Posterior pole color fundus photograph: 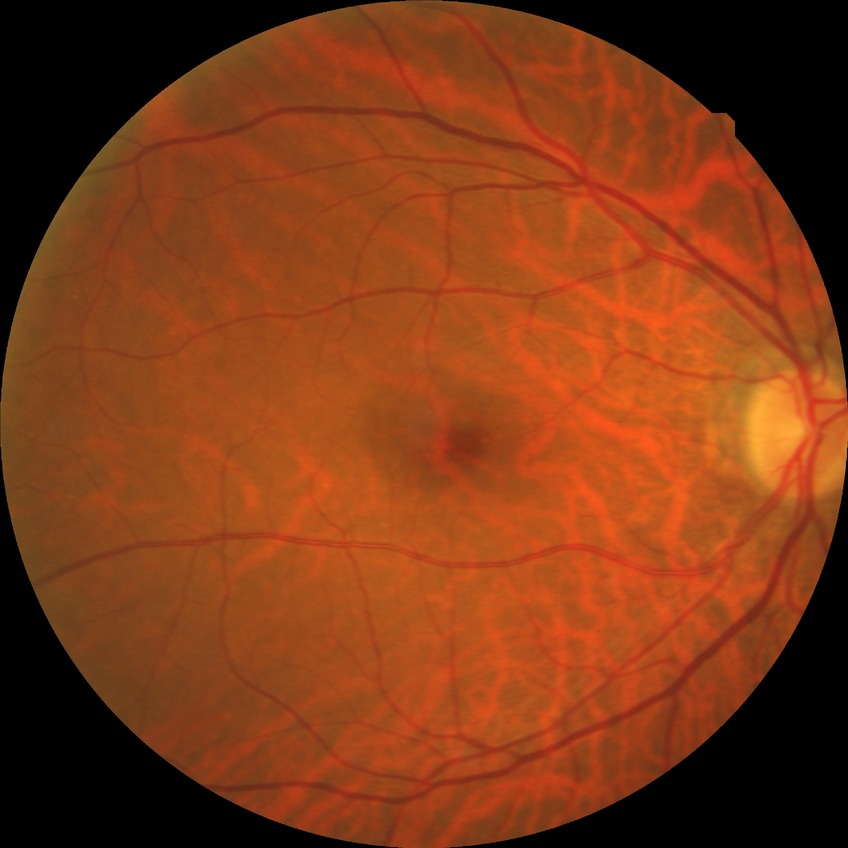
{"davis_grade": "NDR (no diabetic retinopathy)"}